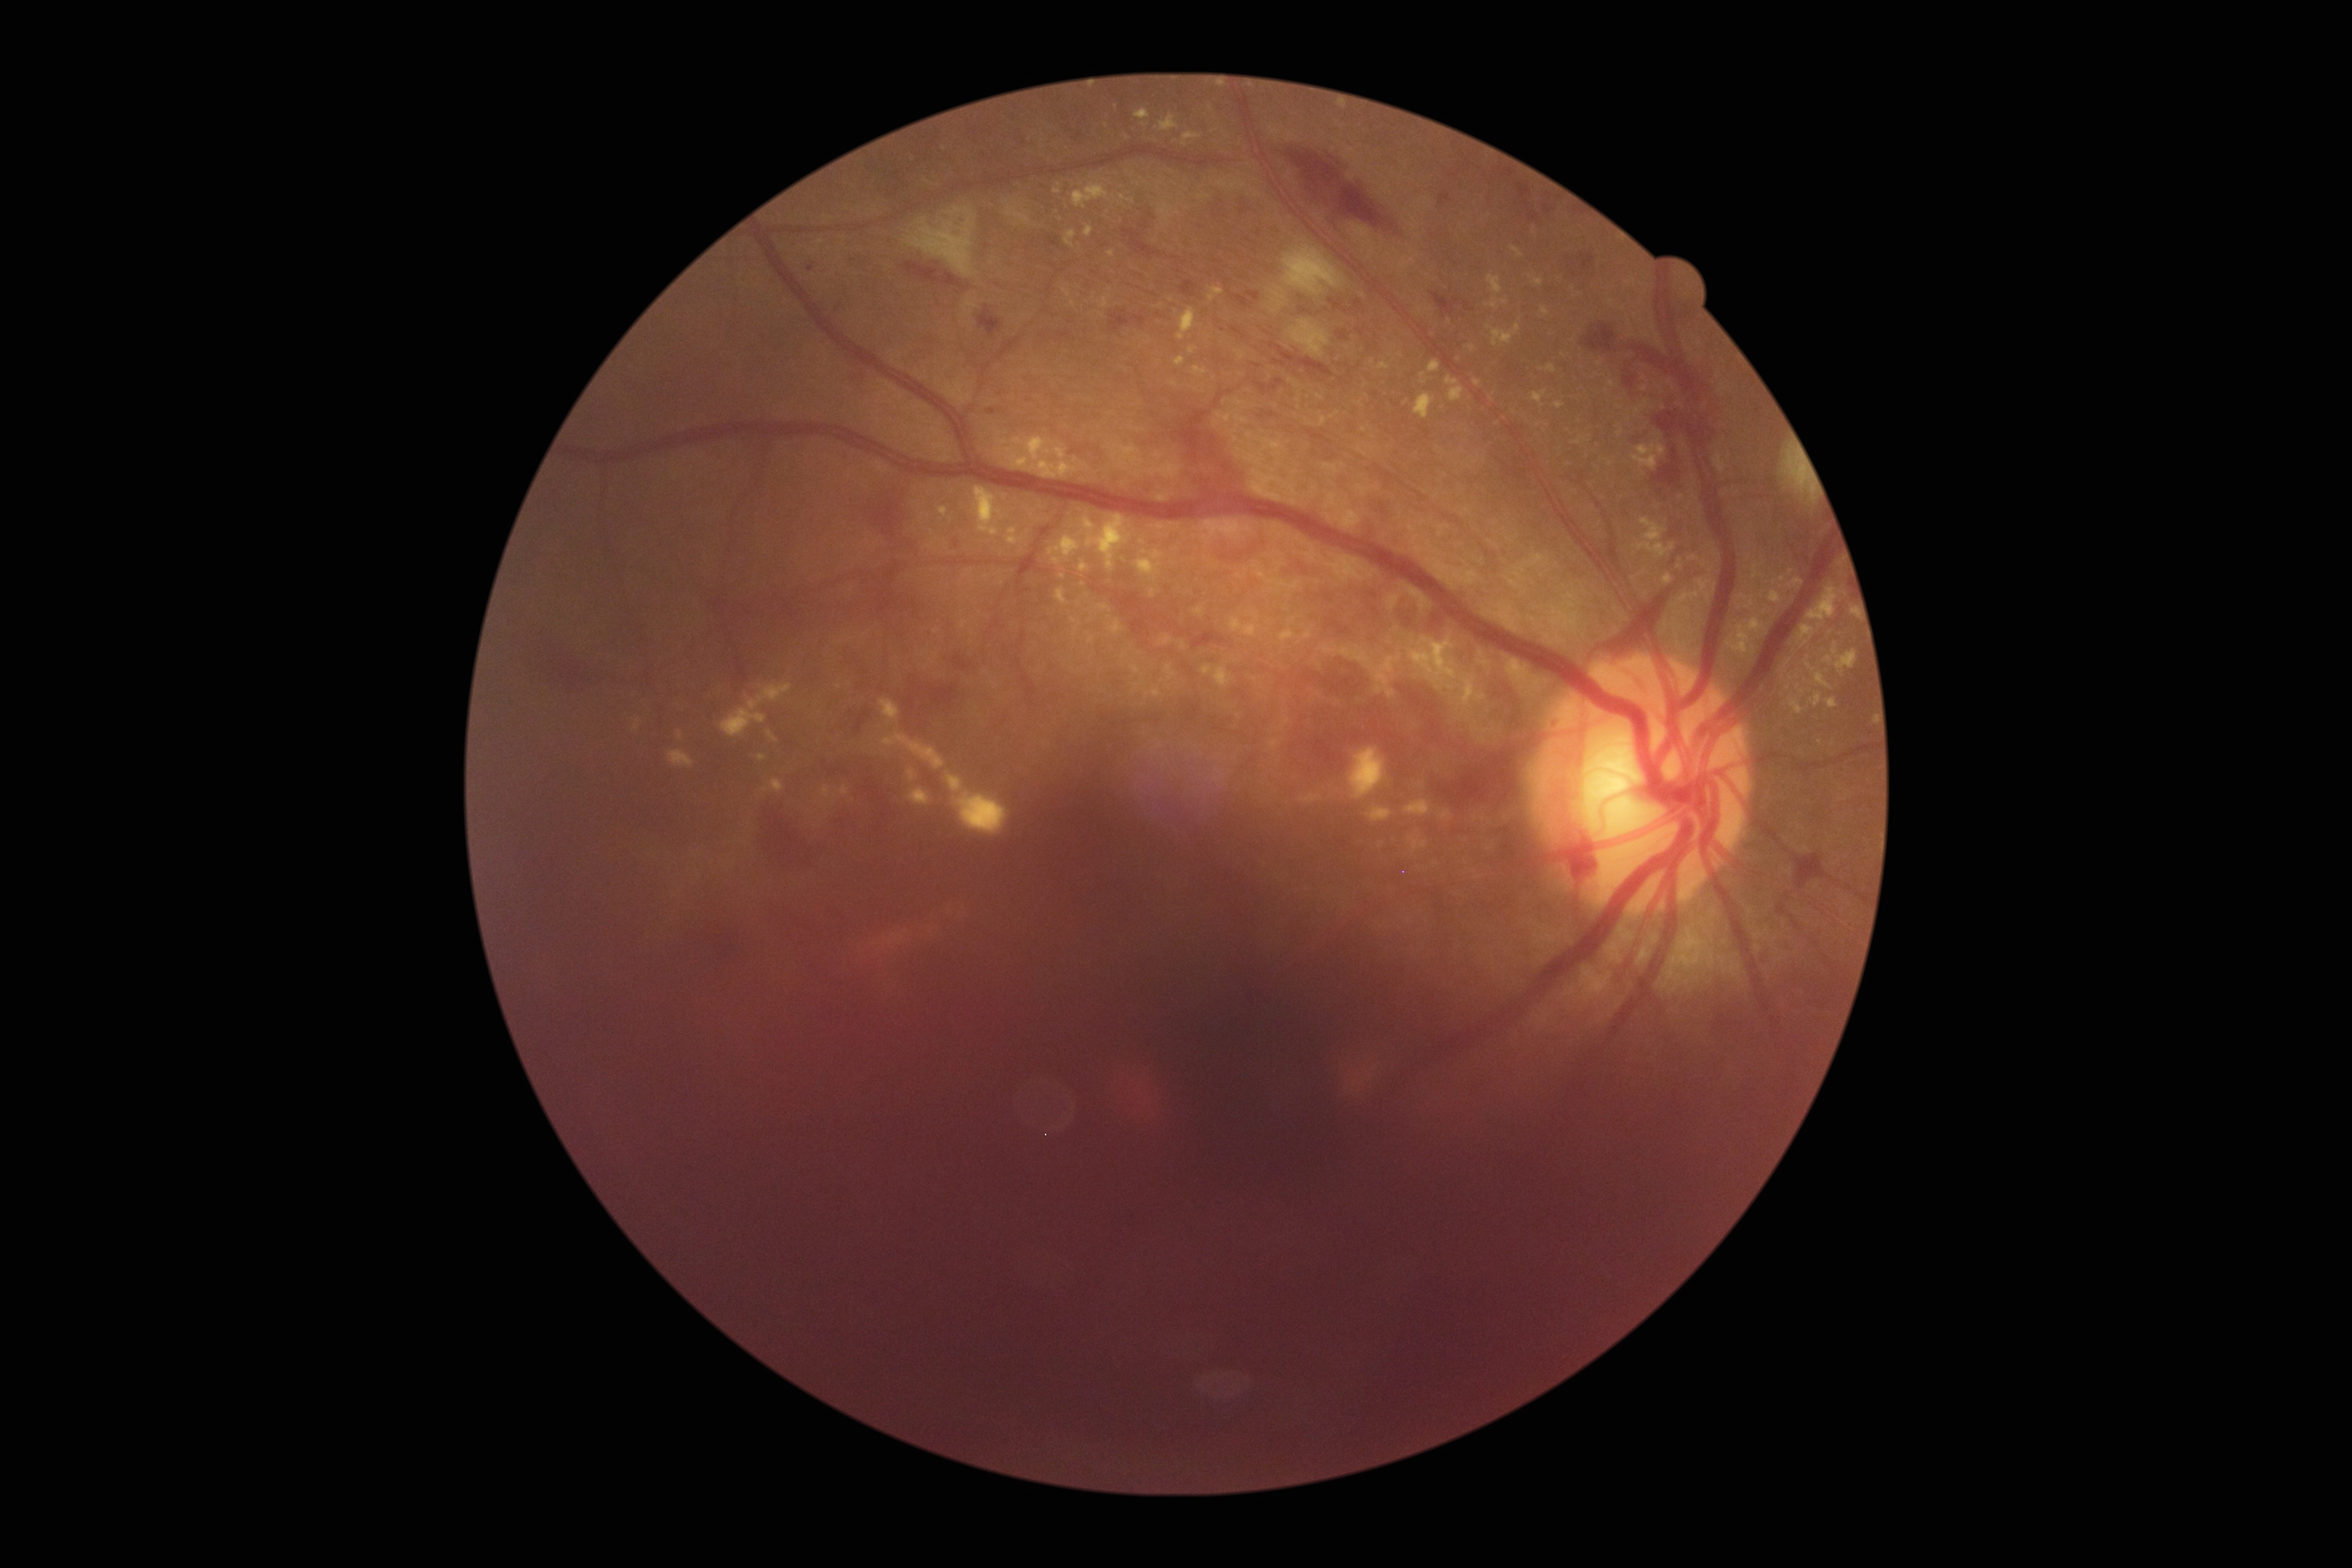 DR grade: proliferative diabetic retinopathy (4).